45° field of view: 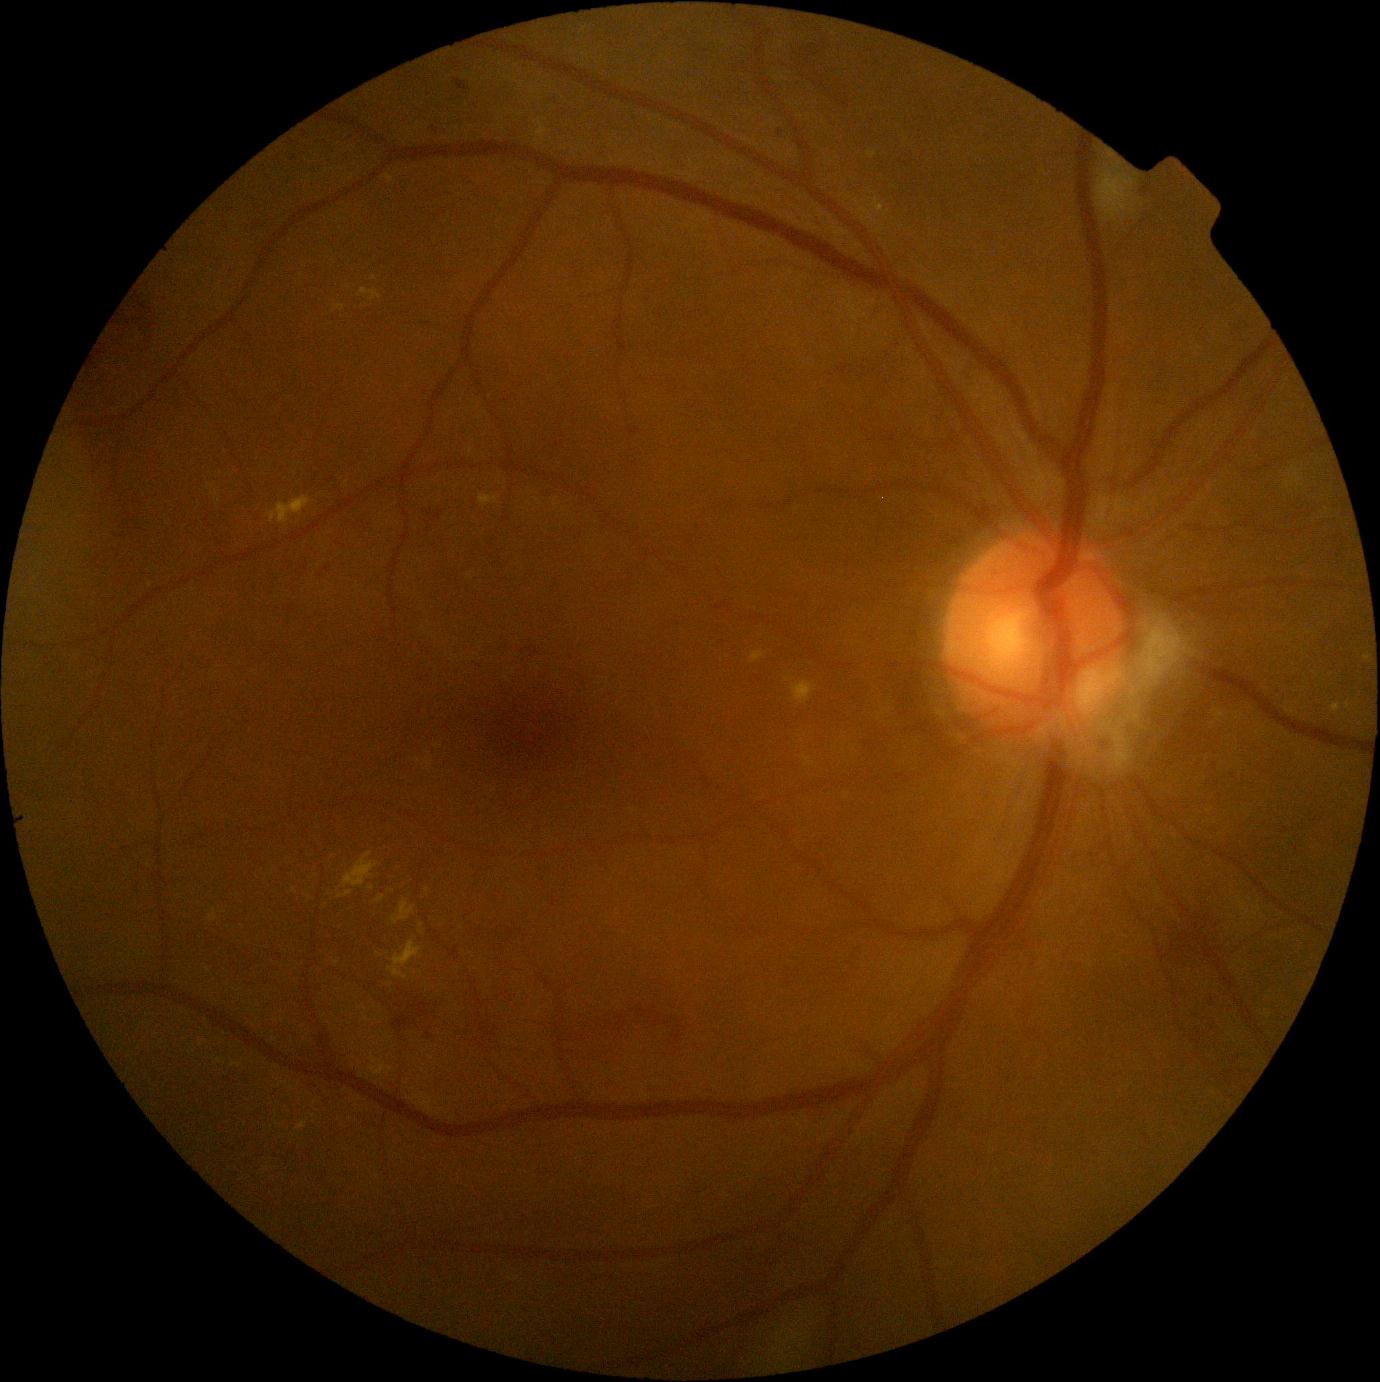

diabetic retinopathy (DR) = 2/4